No pharmacologic dilation. Diabetic retinopathy graded by the modified Davis classification. CFP. 45-degree field of view. Image size 848x848 — 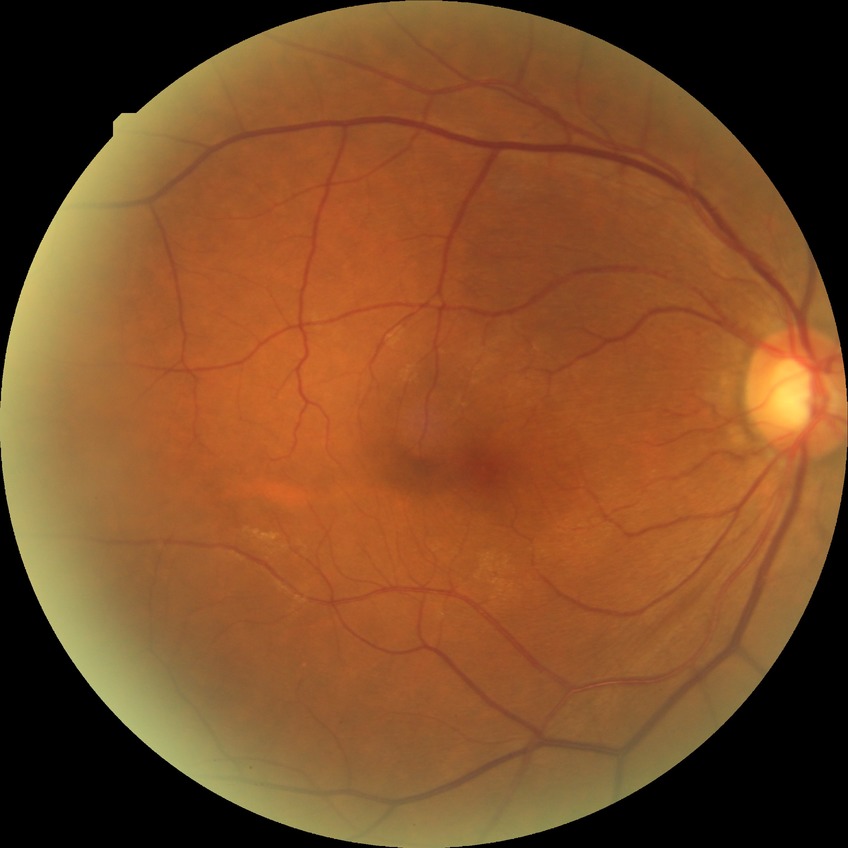 retinopathy grade = no diabetic retinopathy